Dilated-pupil acquisition. CFP. Camera: Topcon TRC-50DX
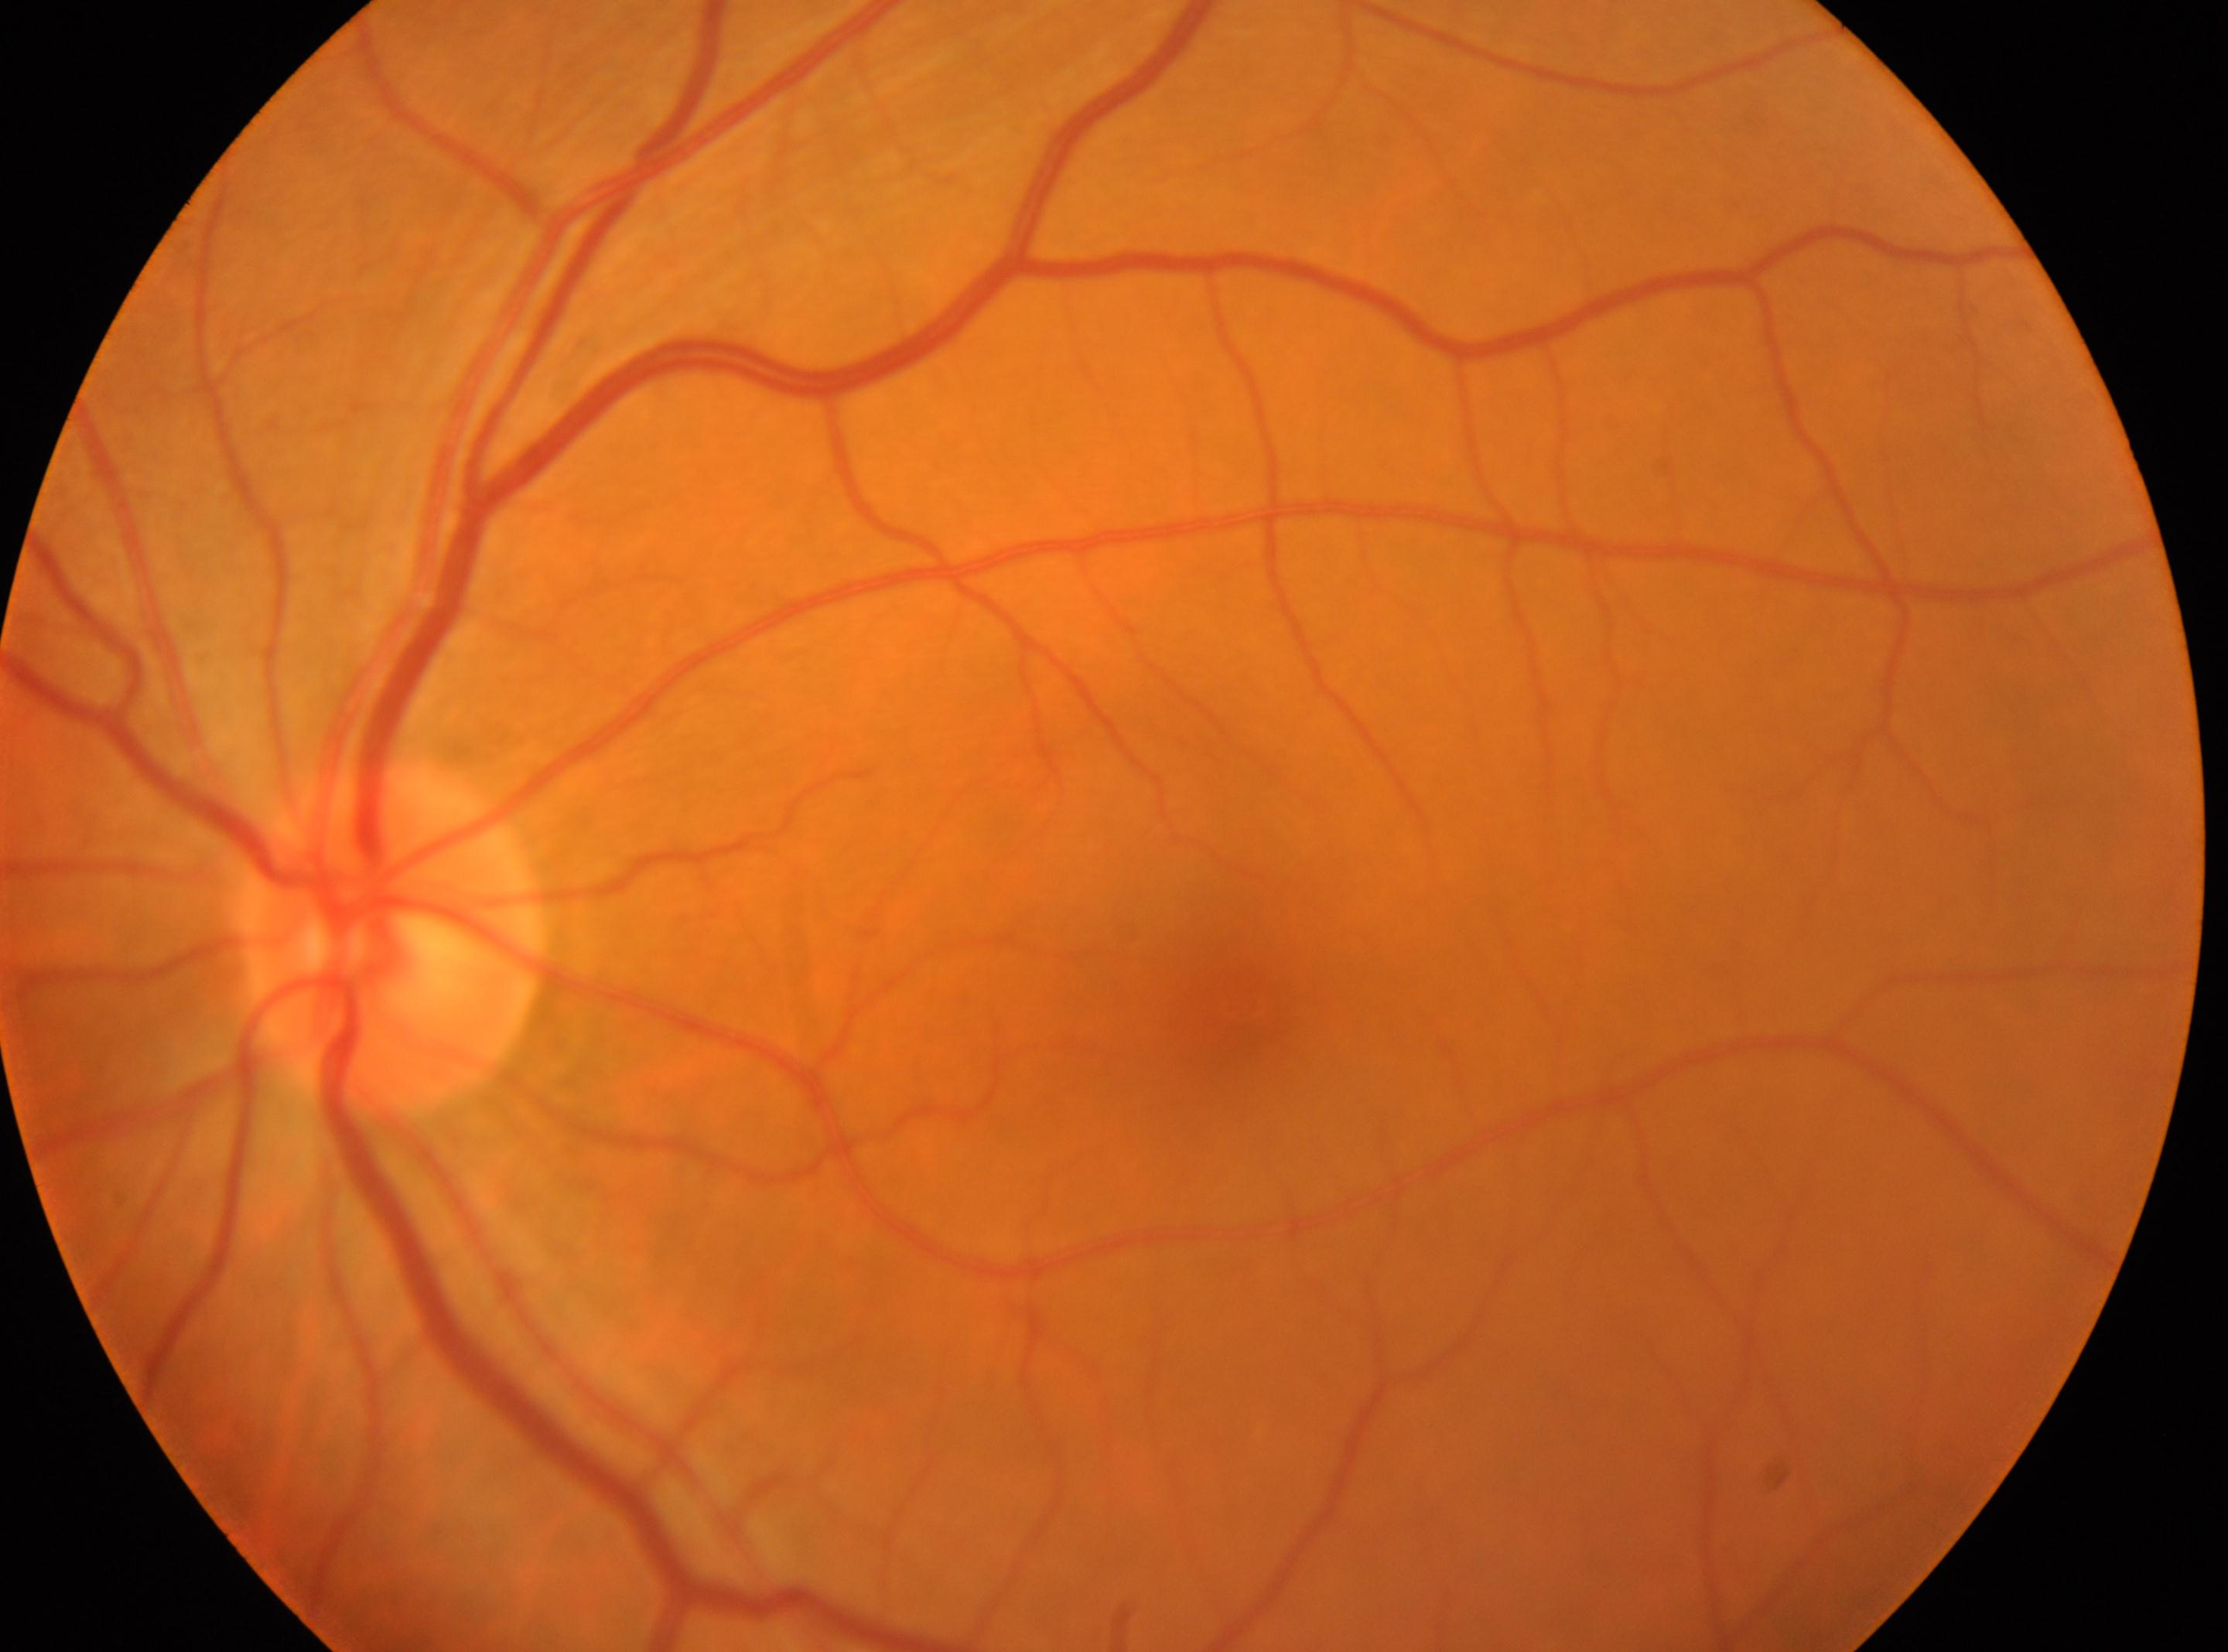

Annotations:
– eye: OS
– diabetic retinopathy (DR): no apparent retinopathy (grade 0)
– optic disc center: 391px, 940px
– macular center: 1241px, 1004px